Infant wide-field retinal image · 1240x1240px:
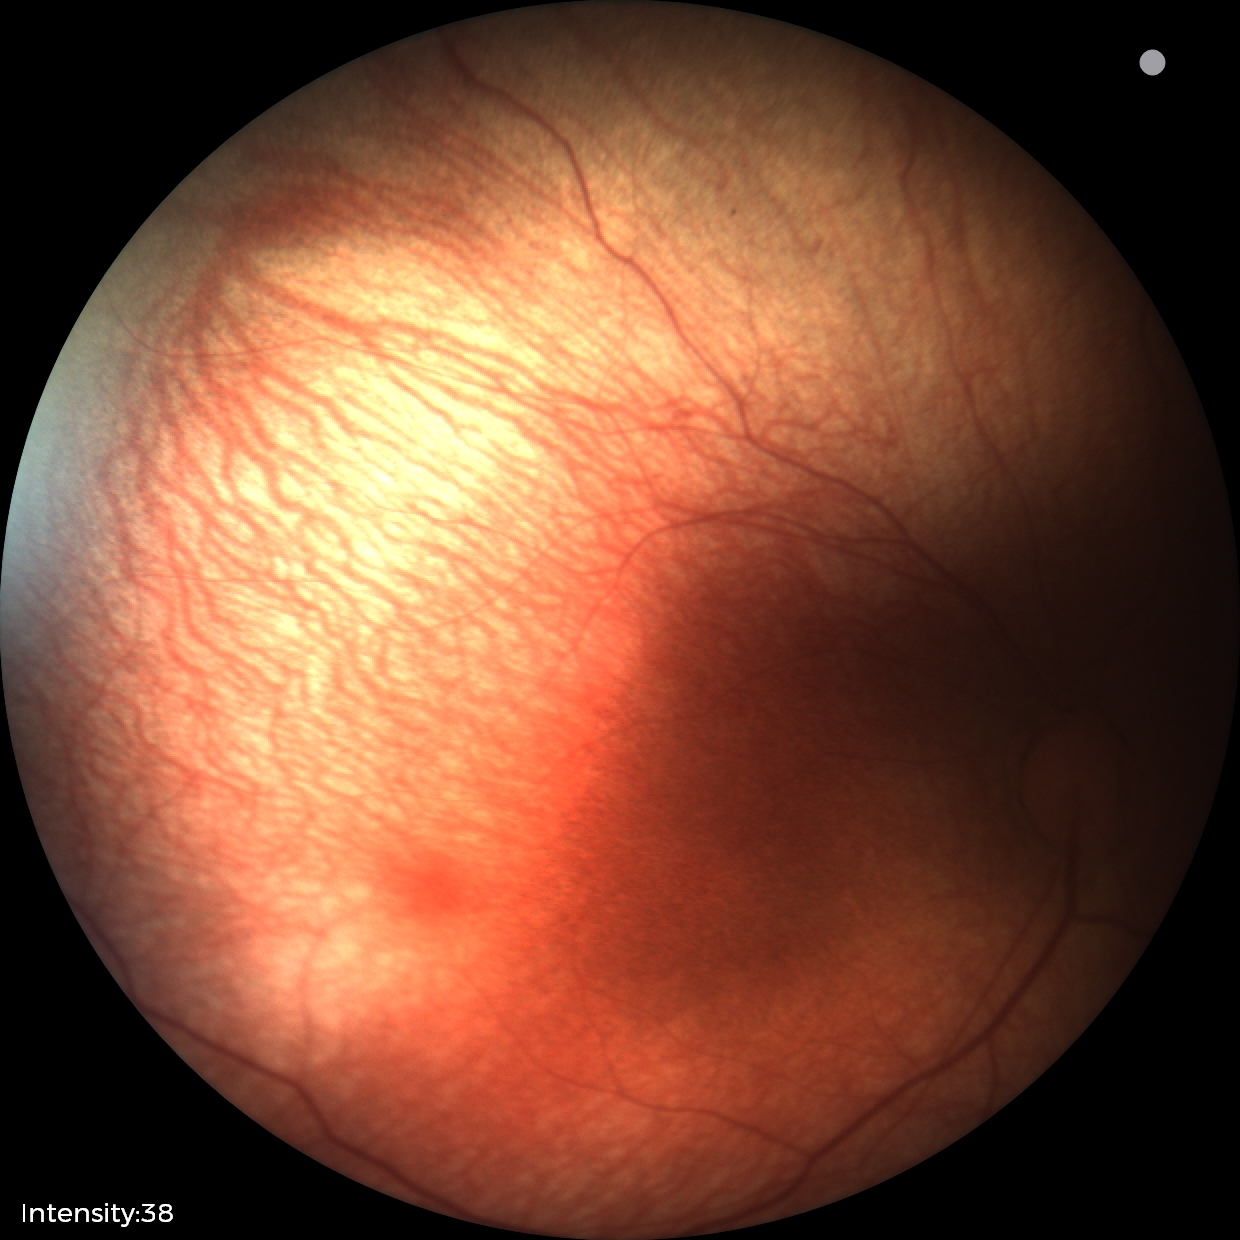 Q: What is the diagnosis from this examination?
A: physiological retinal finding